848x848; nonmydriatic — 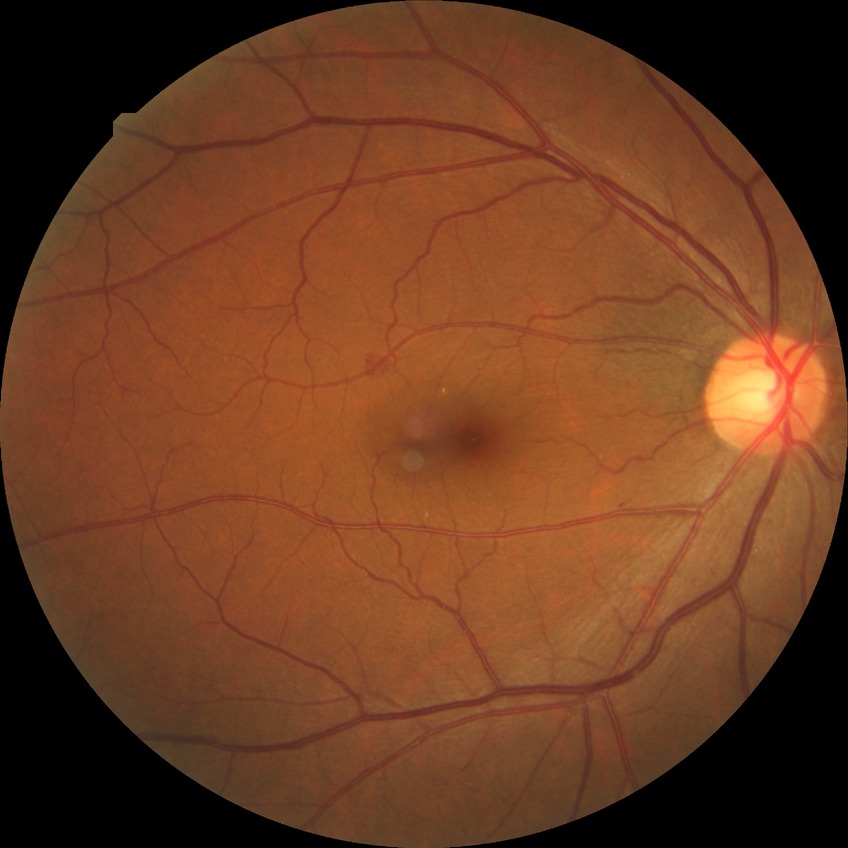 DR impression@no signs of DR; Davis stage@NDR.